FOV: 45 degrees · 1960x1897 · color fundus photograph: 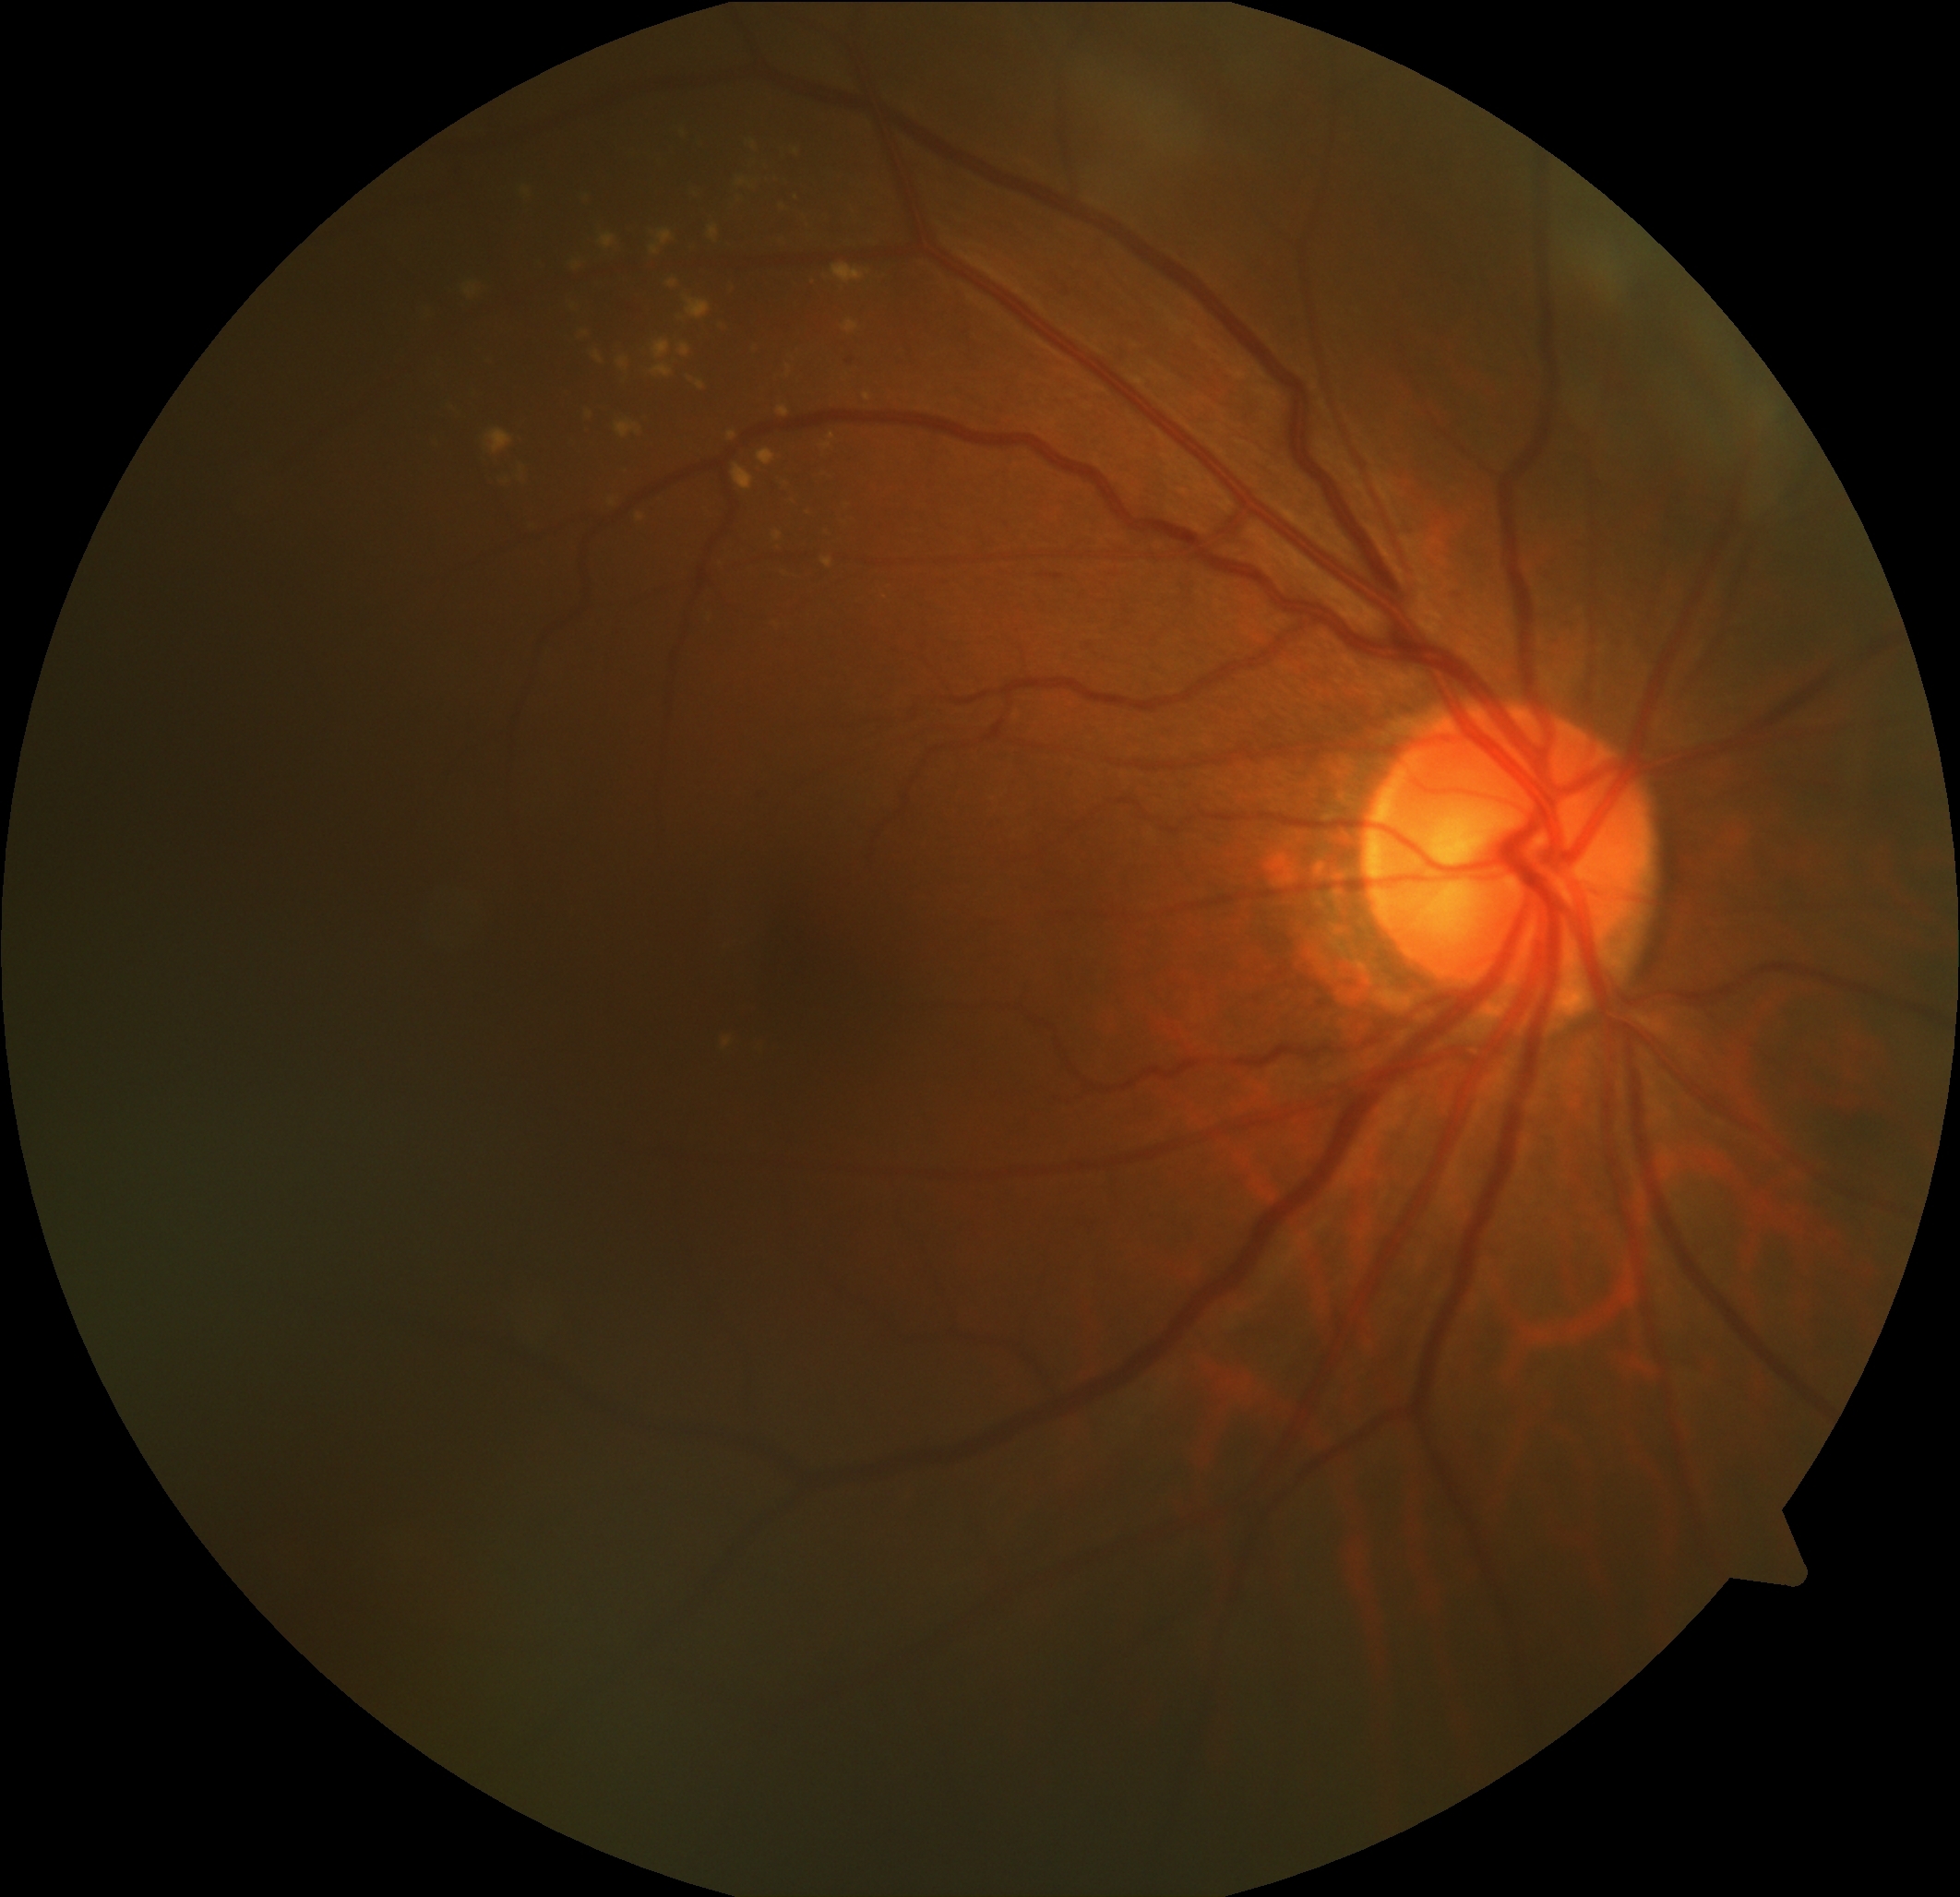 DR severity@2.